2352 by 1568 pixels. FOV: 45 degrees. CFP: 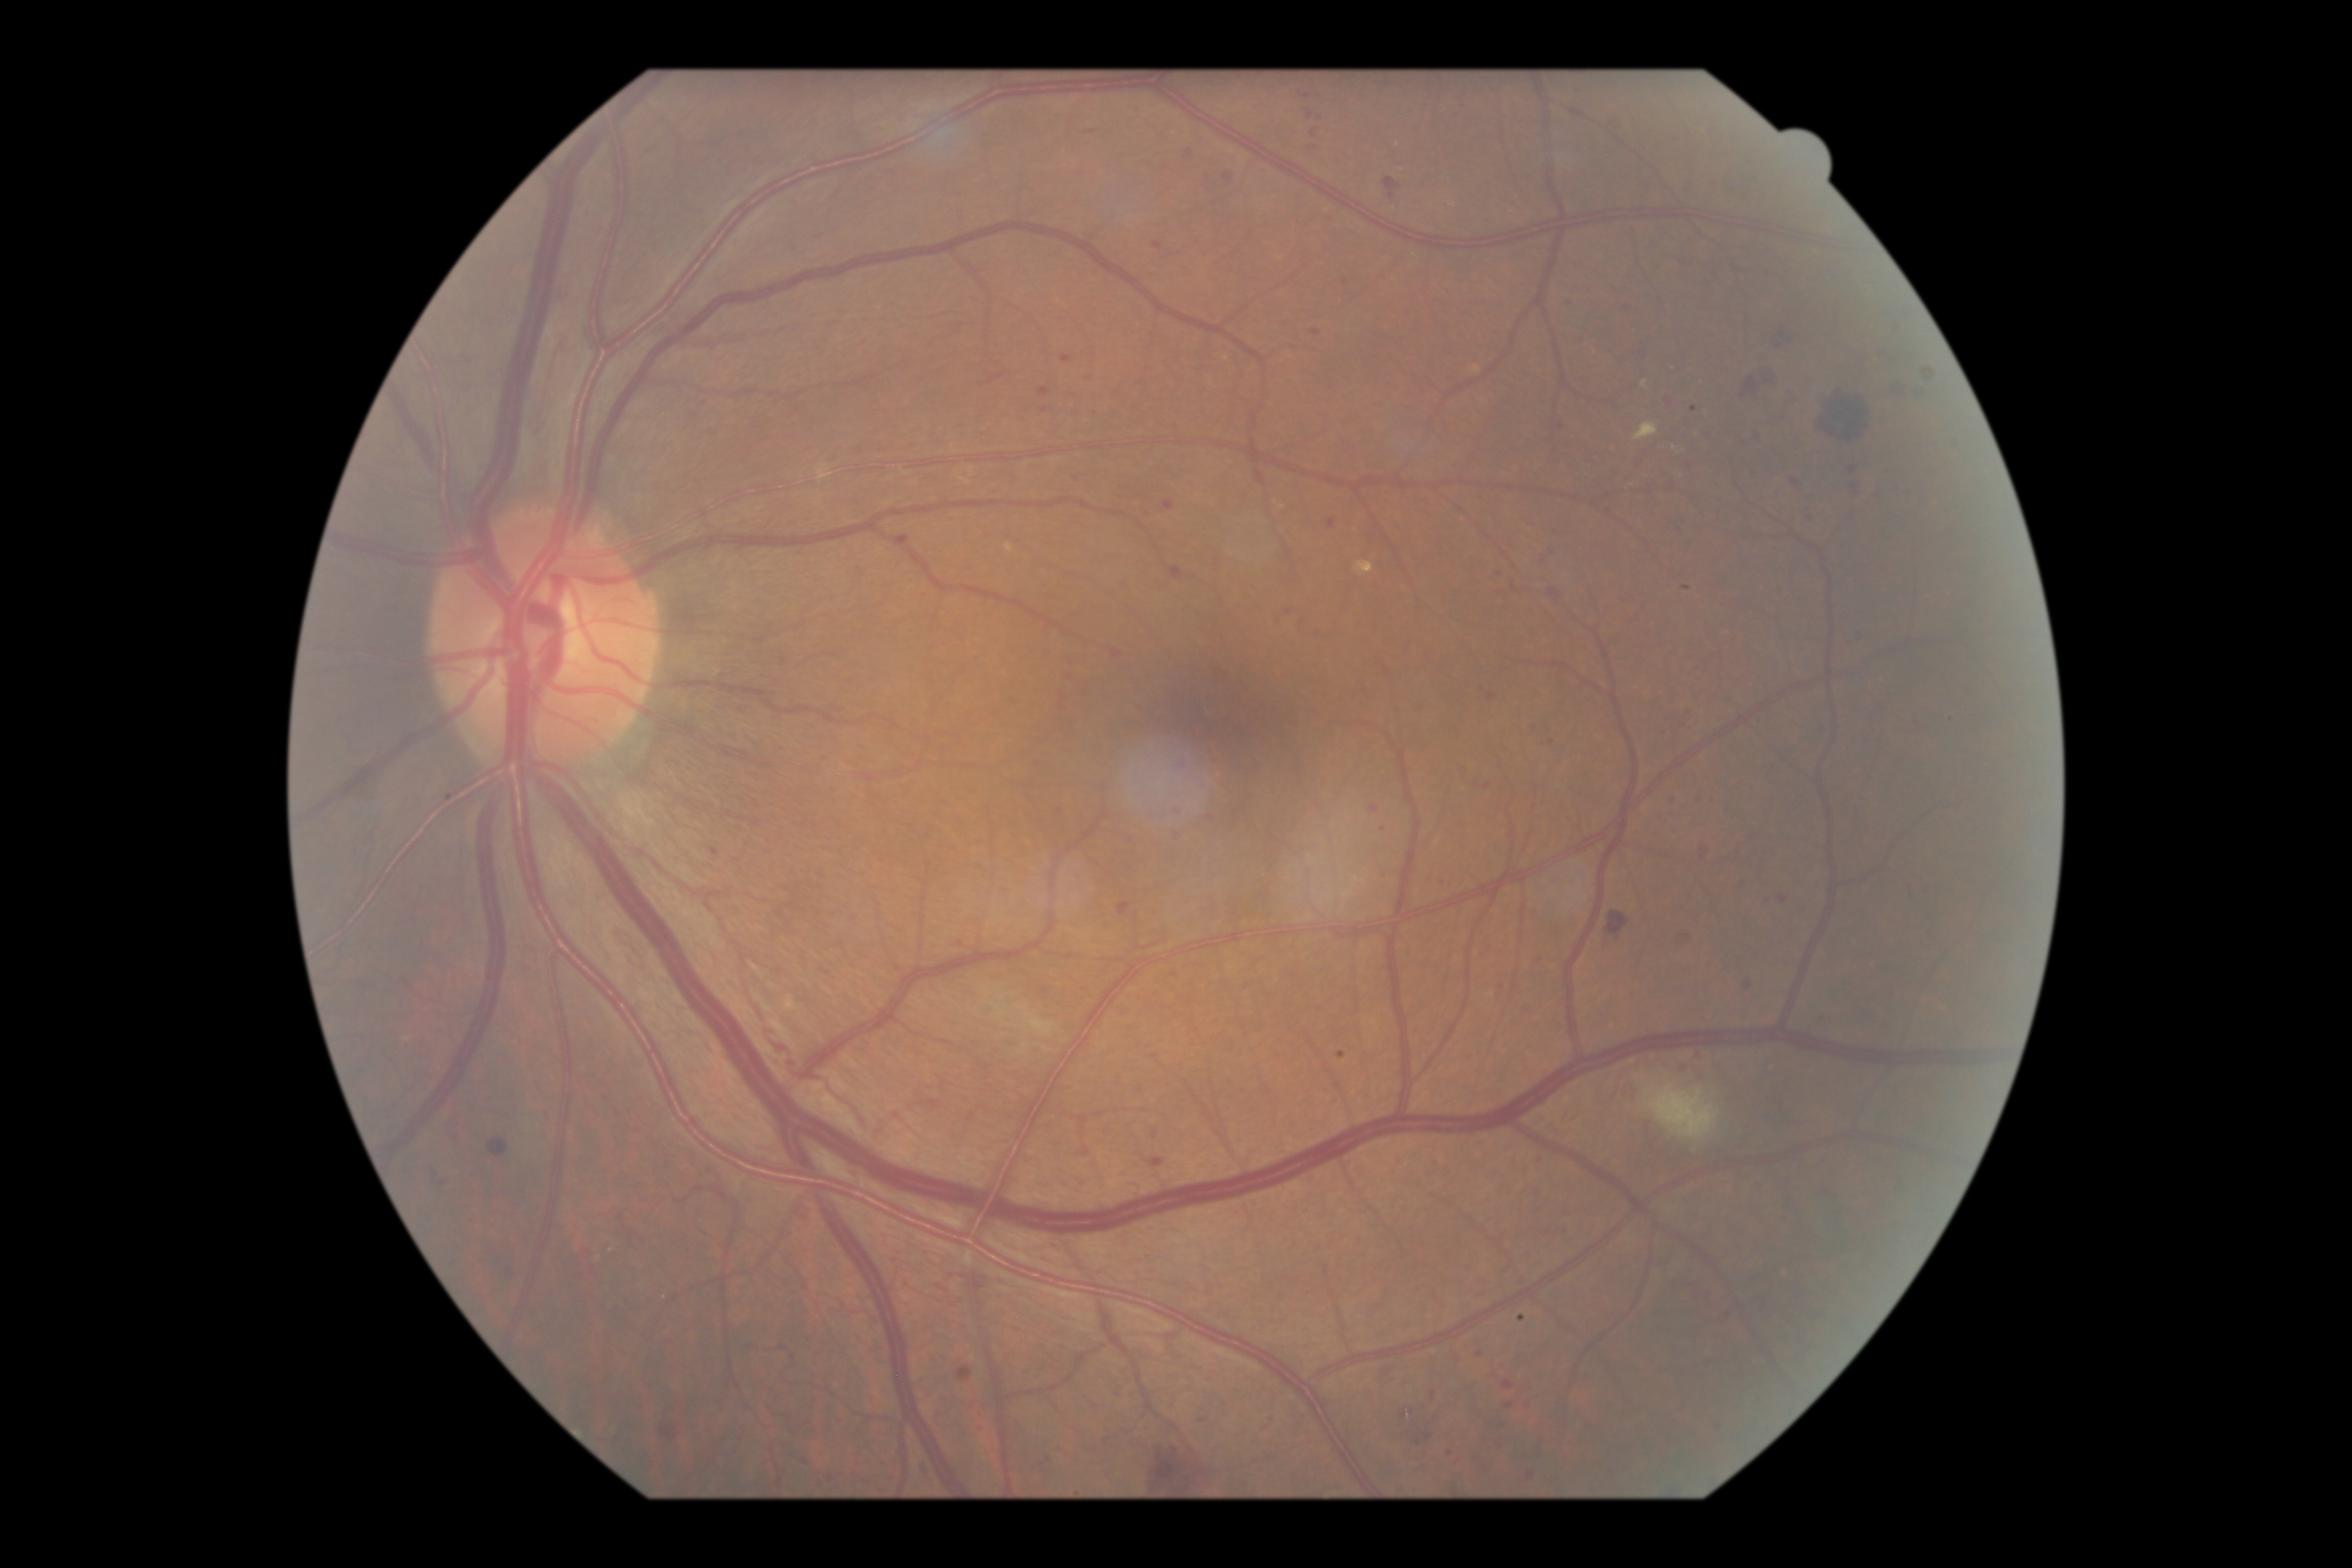 – retinopathy grade — 2/4